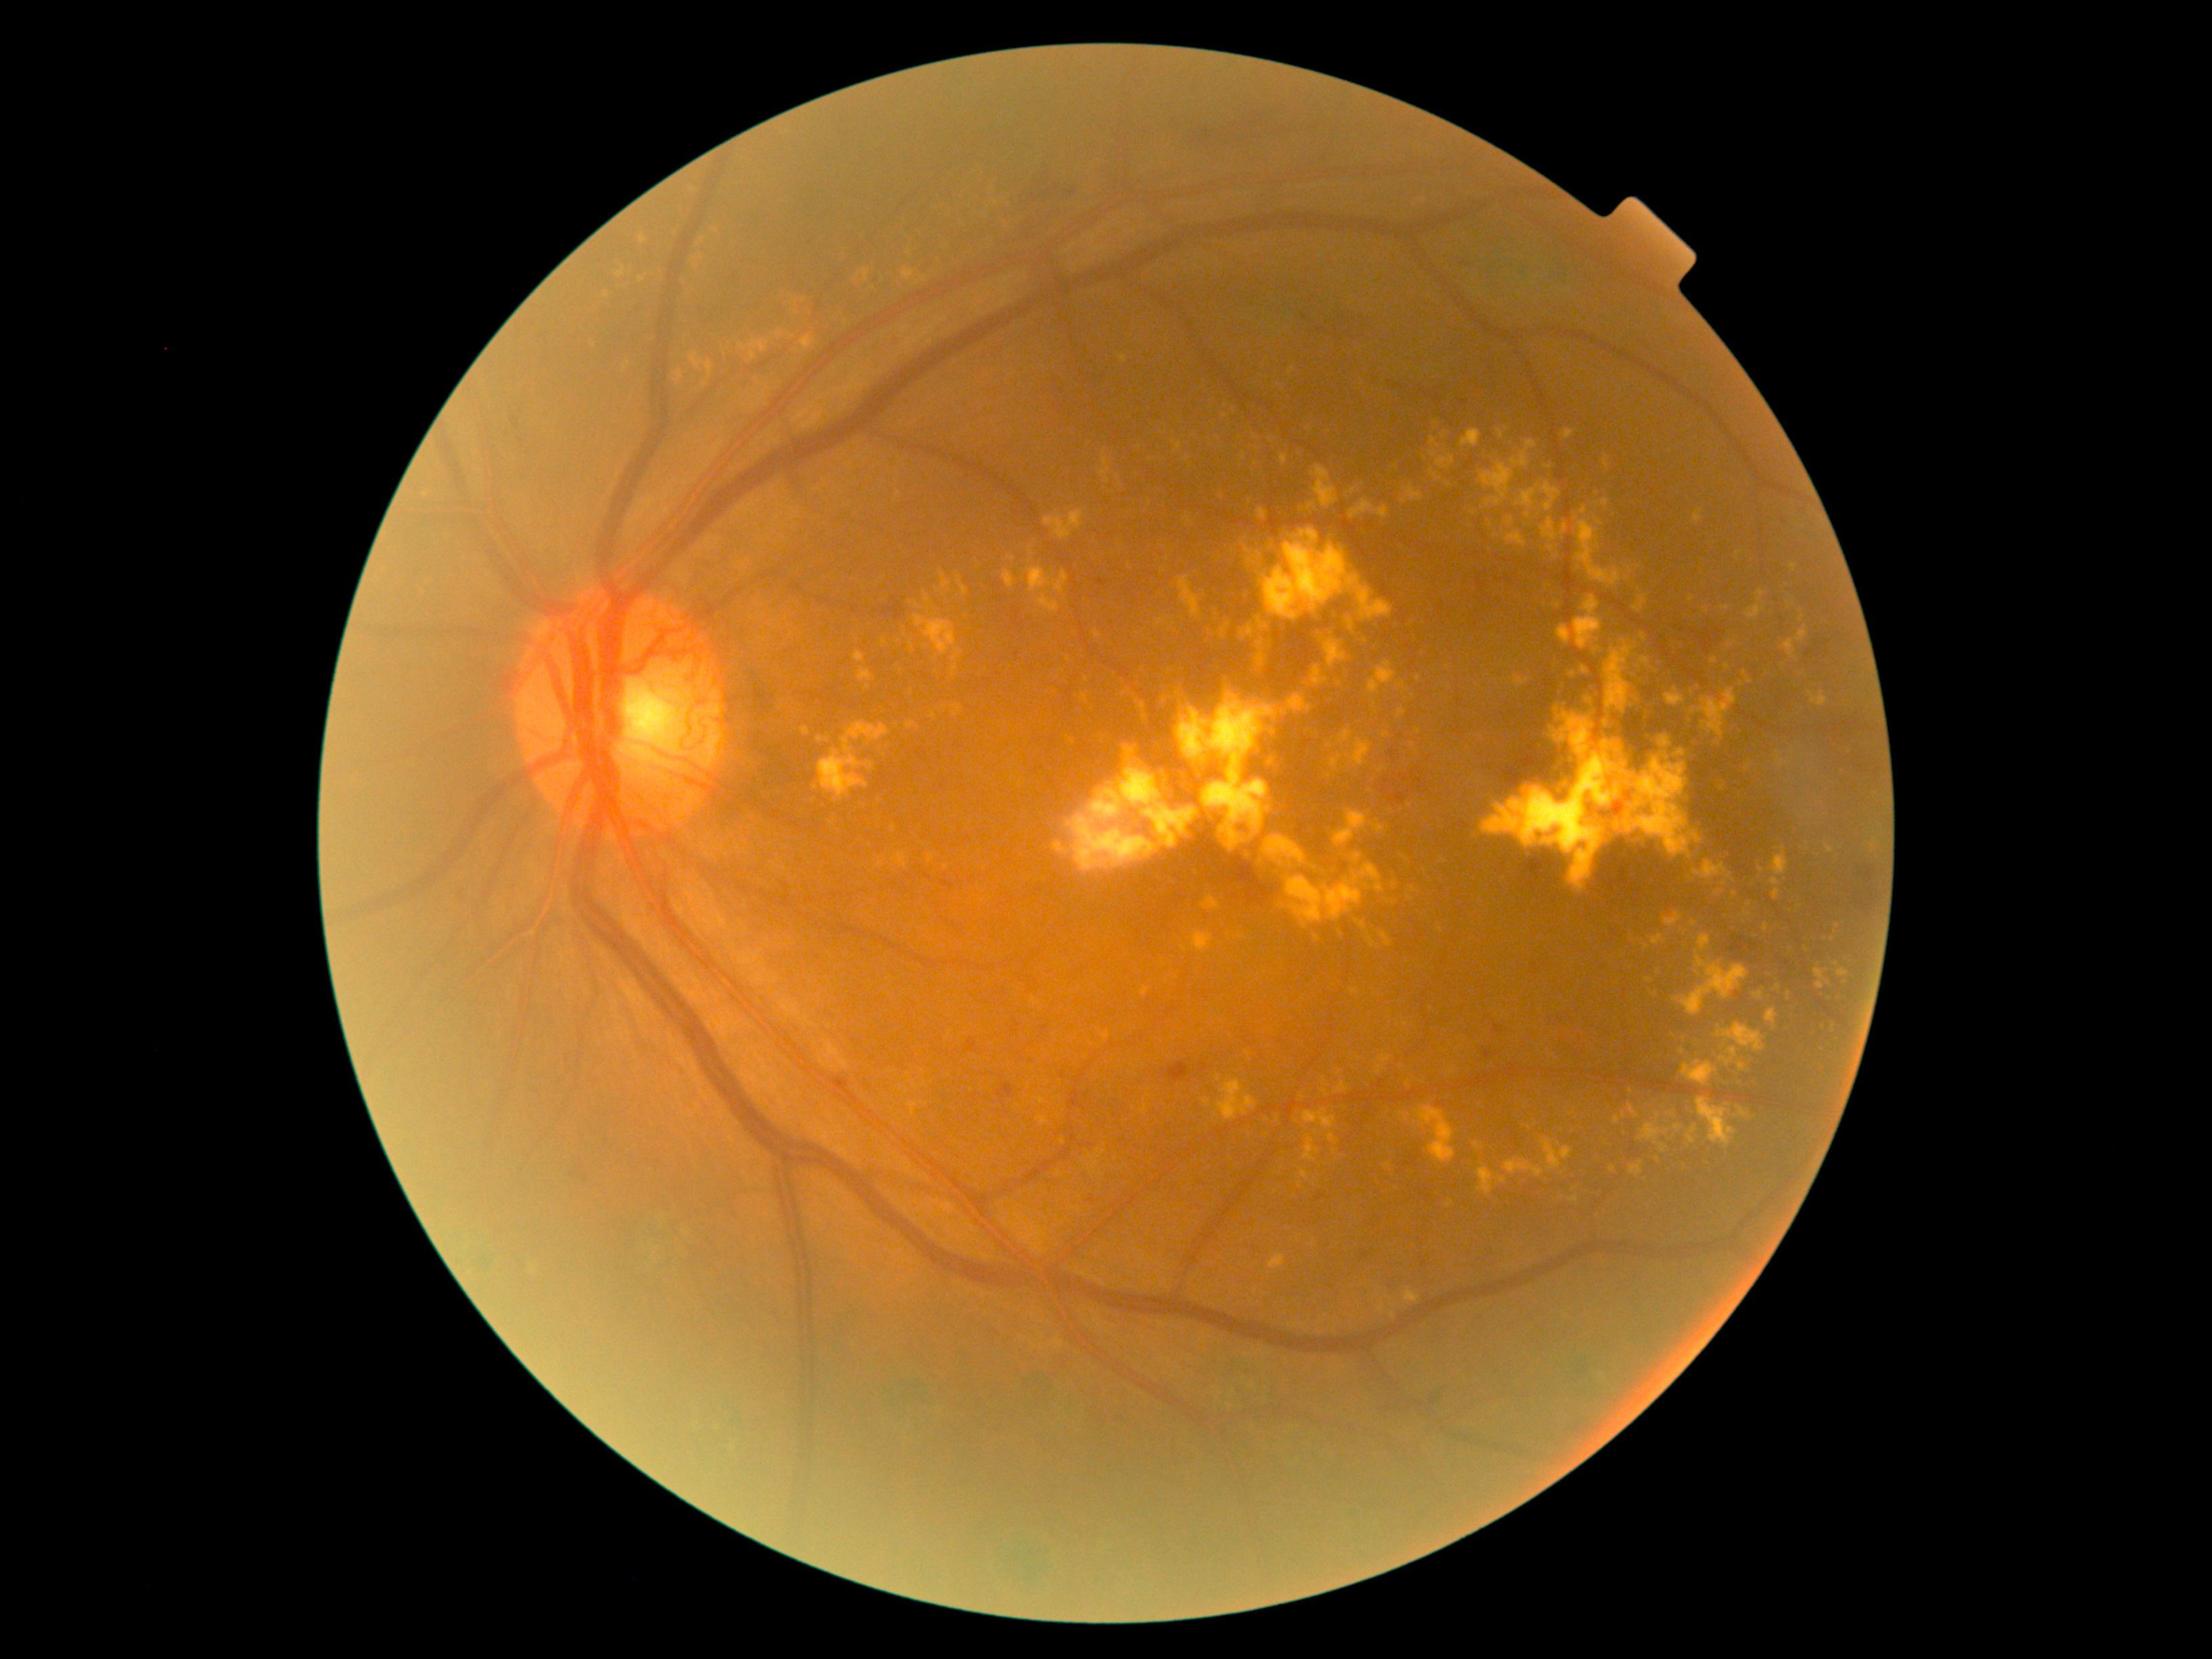

Diabetic retinopathy (DR) is grade 4
Lesions identified (partial list):
hard exudates (EXs) (subset): [1265, 837, 1315, 874] | [1516, 486, 1539, 520] | [1681, 872, 1685, 882] | [1787, 991, 1790, 1000] | [1260, 857, 1271, 869] | [1263, 626, 1271, 631] | [925, 593, 930, 602] | [1681, 1124, 1698, 1149] | [936, 668, 941, 678] | [616, 268, 626, 279] | [1515, 676, 1530, 688] | [1280, 455, 1288, 466] | [909, 689, 914, 701] | [1404, 1288, 1420, 1303]
Smaller EXs around 1726, 667 | 923, 279 | 1243, 456 | 1491, 526 | 1706, 610 | 1579, 764